Color fundus photograph; image size 2352x1568; 45° field of view.
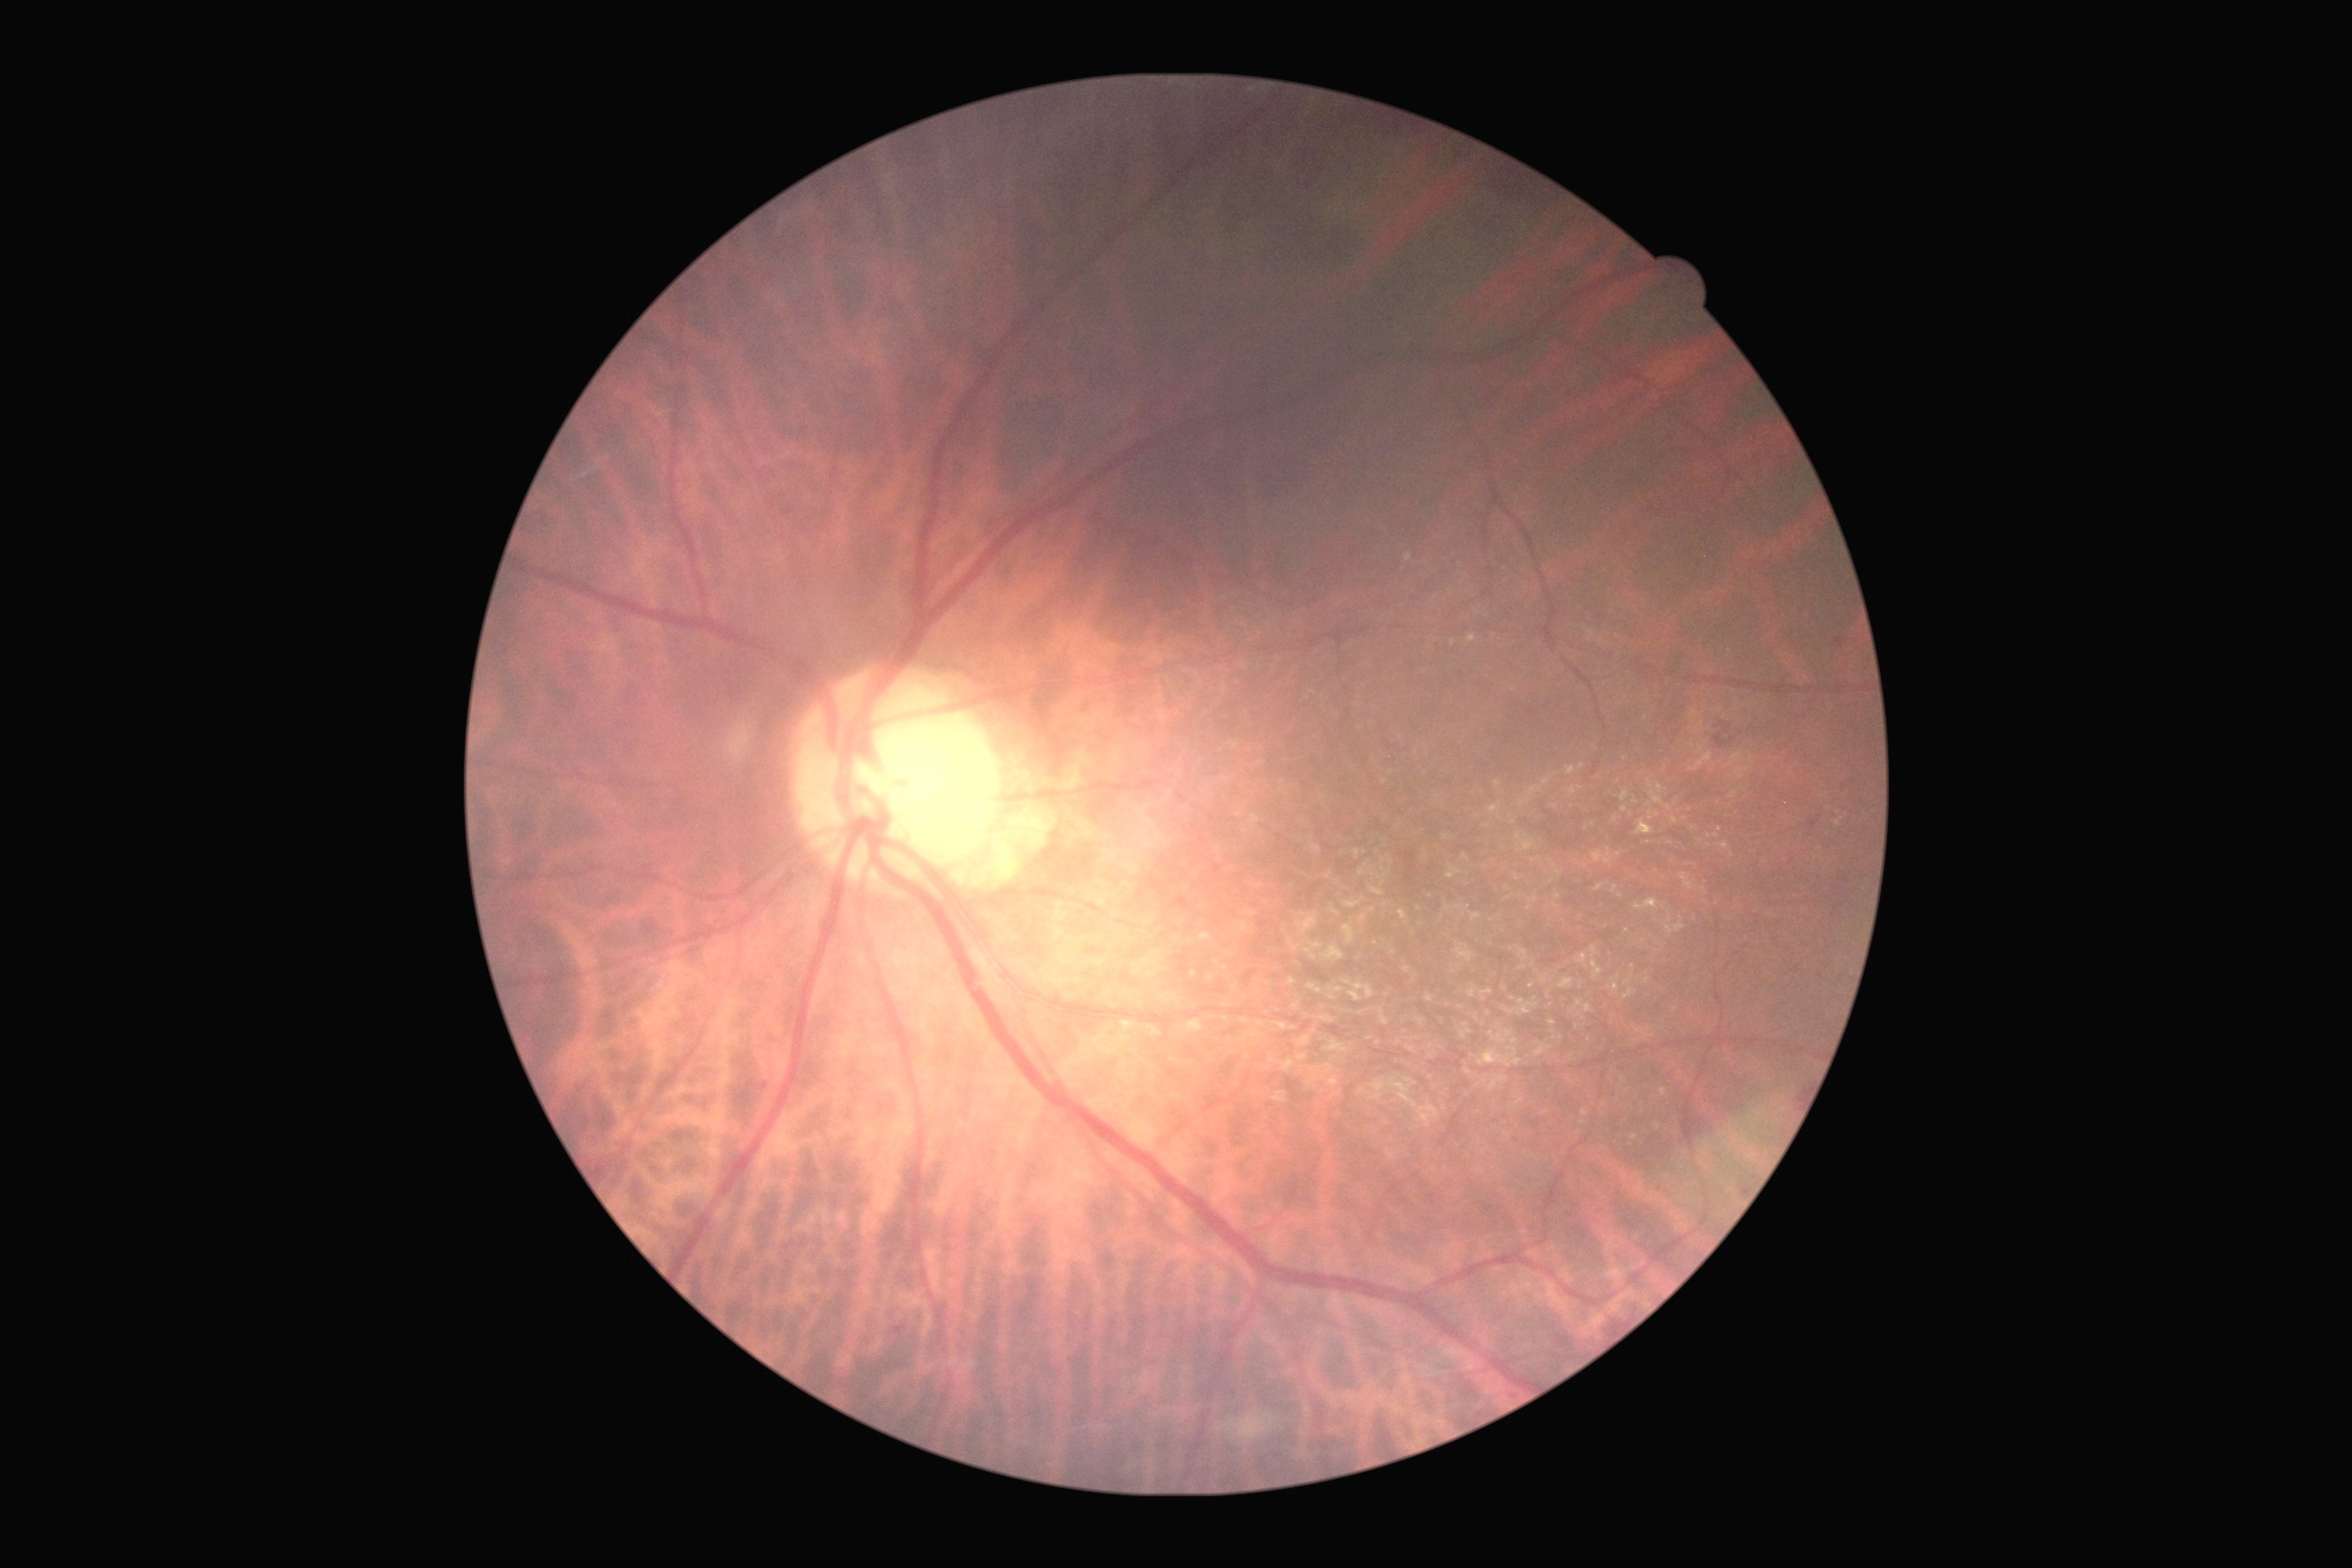

Annotations:
• diabetic retinopathy — moderate NPDR (grade 2)